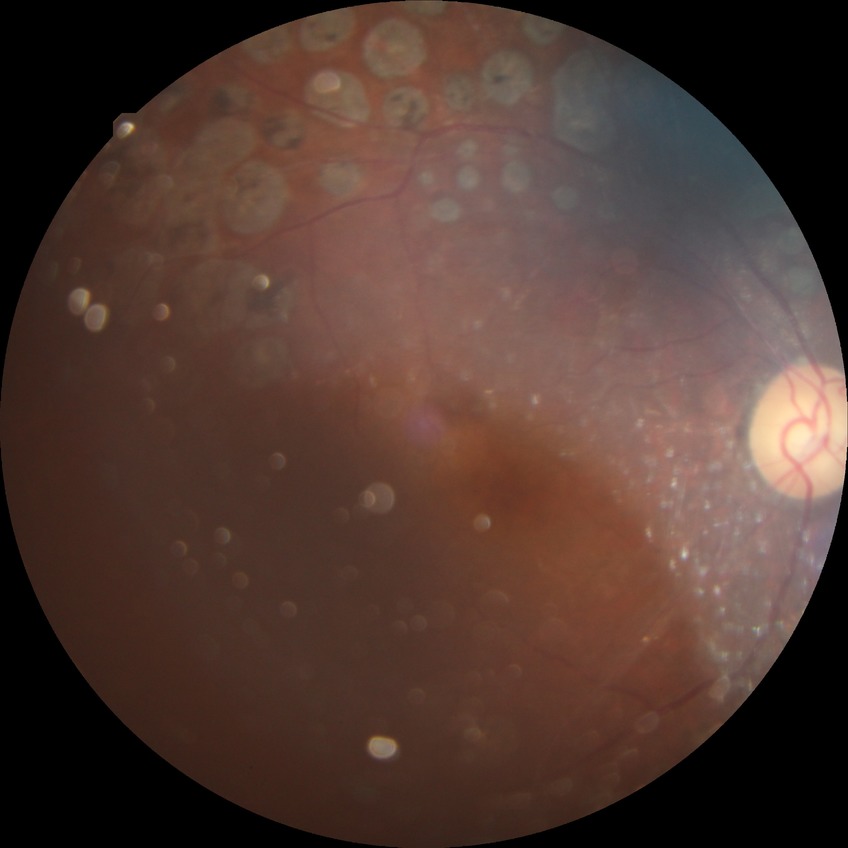

Diabetic retinopathy stage is proliferative diabetic retinopathy.